ONH-centered crop from a color fundus image — 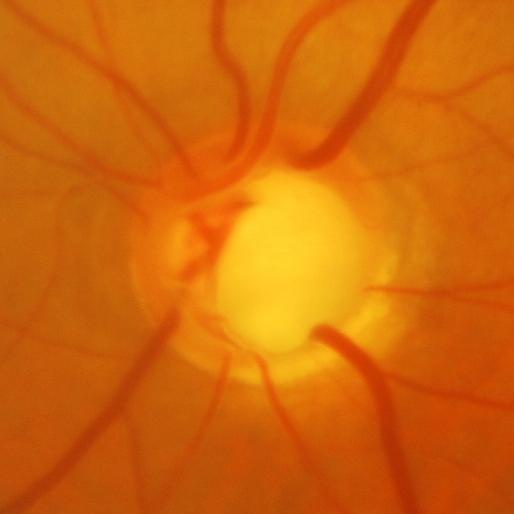
Glaucoma assessment: evidence of glaucoma.